Wide-field fundus image from infant ROP screening: 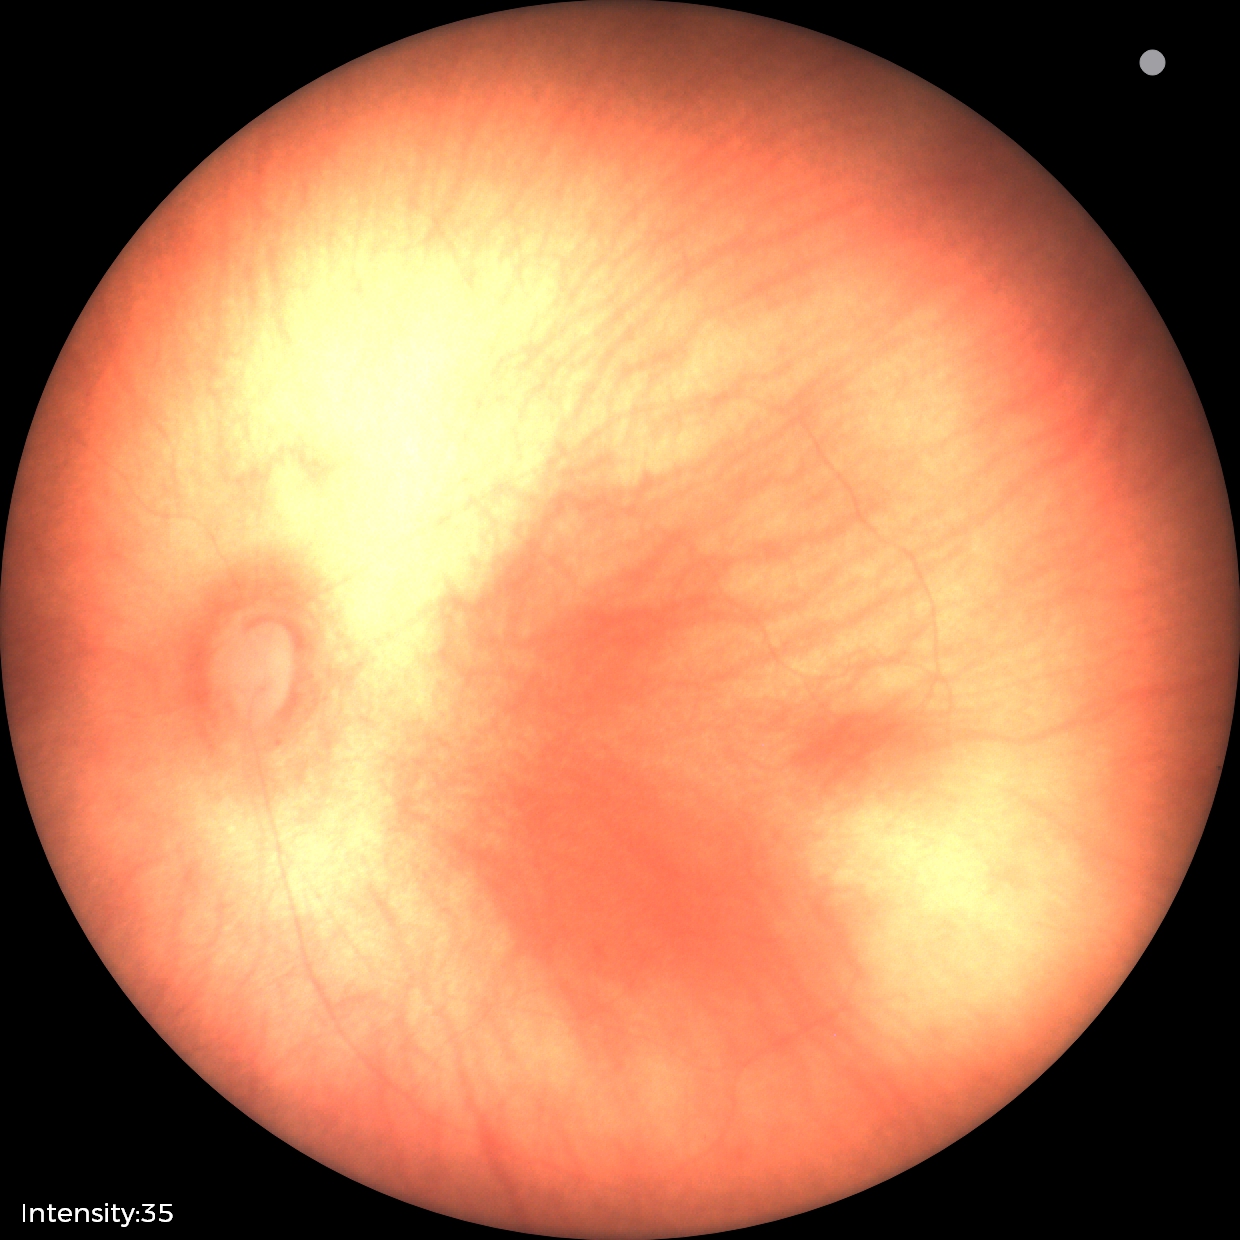
Assessment: normal retinal appearance.